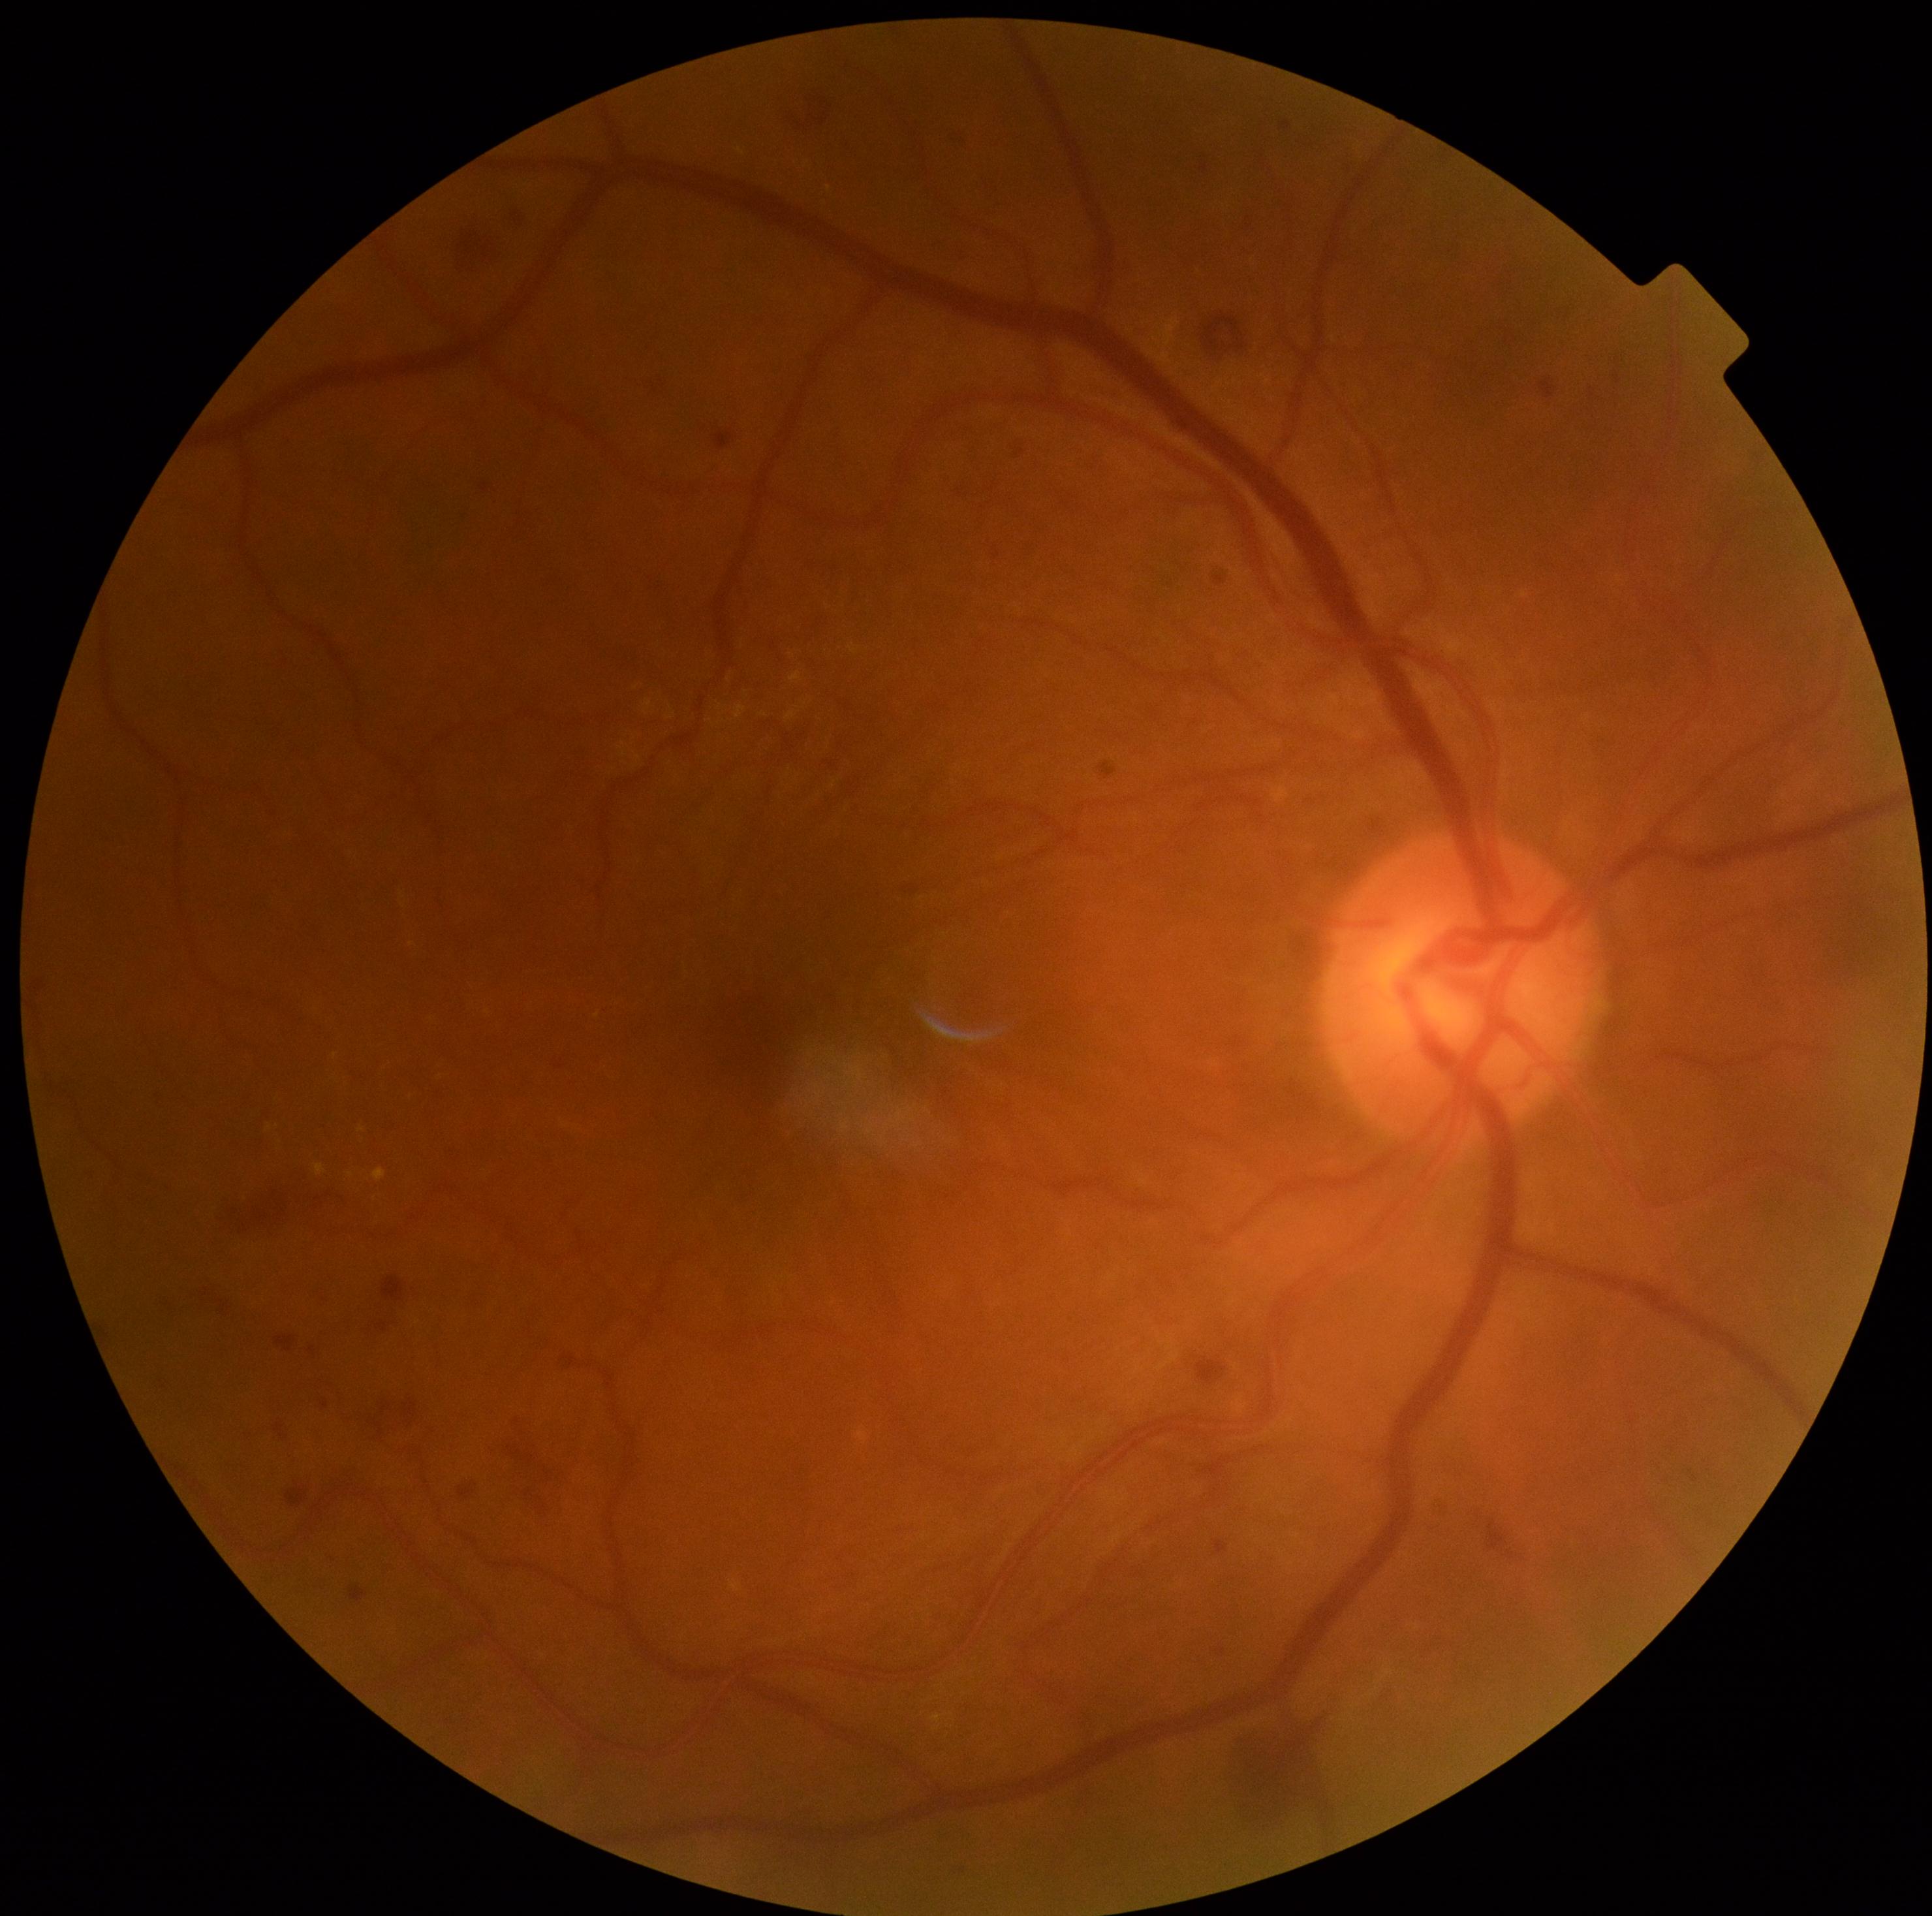
Retinopathy is 2.